Color fundus photograph, 2212x1672px, 45° FOV: 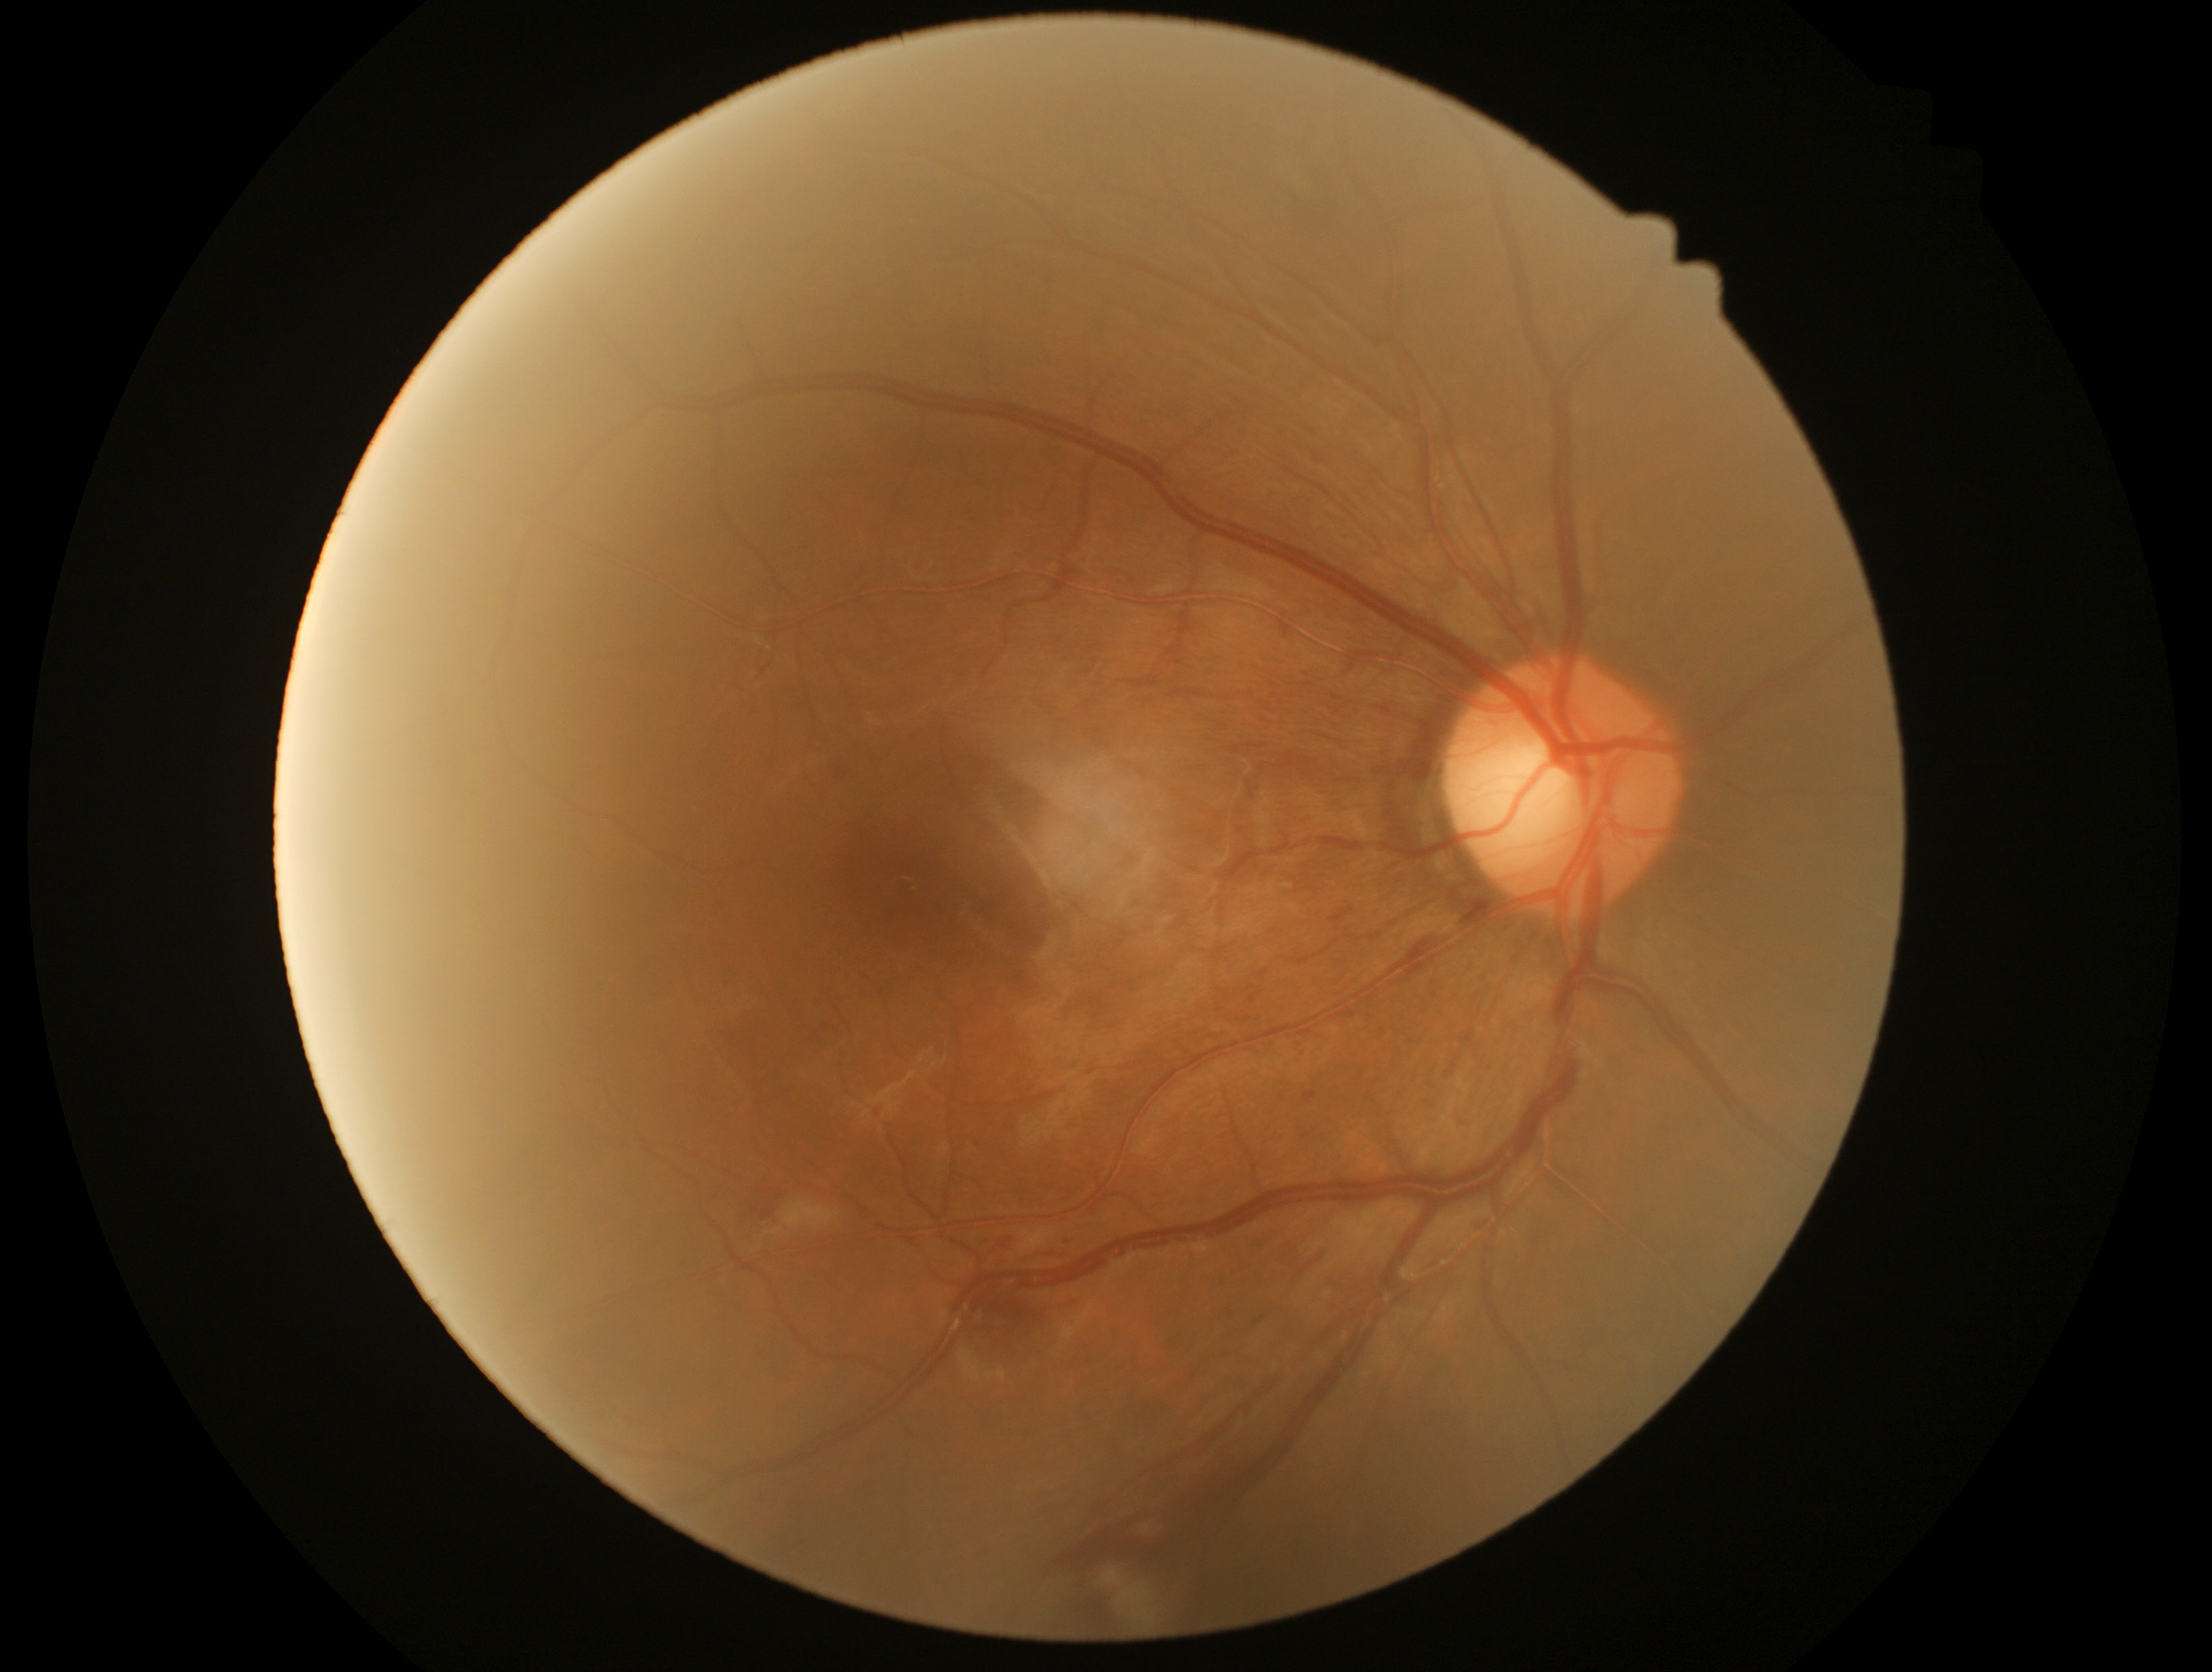
The retinopathy is classified as non-proliferative diabetic retinopathy.
DR grade is moderate NPDR (2).